2048x1536. 45° field of view. Fundus photo — 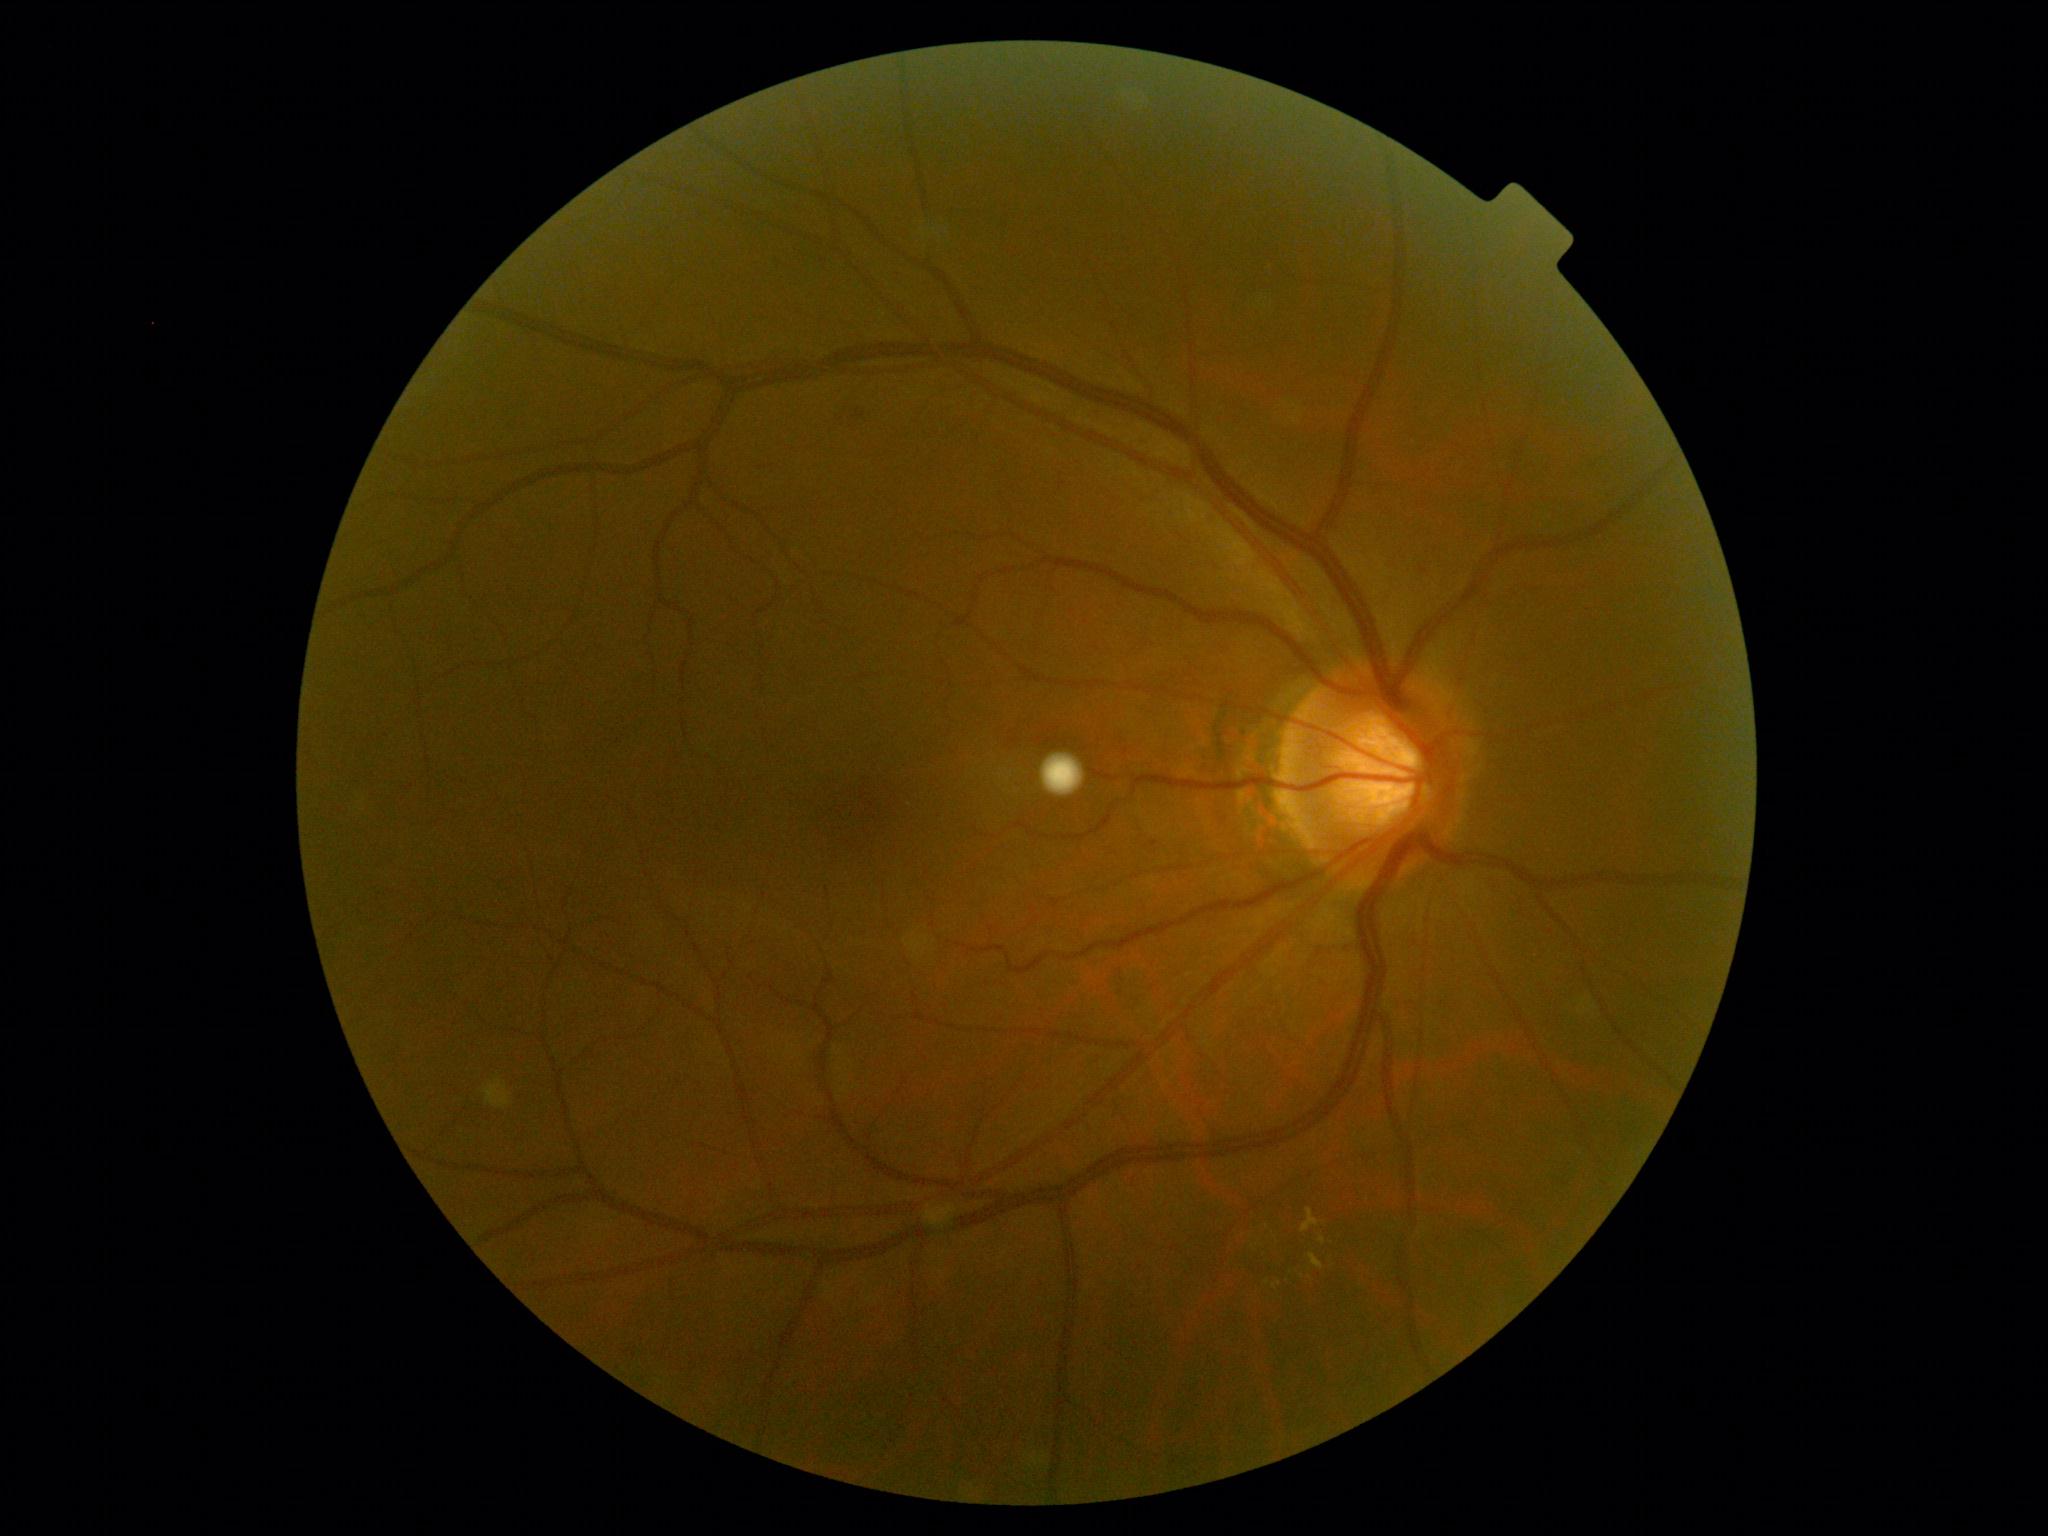 {"dr_grade": "grade 2", "dr_category": "non-proliferative diabetic retinopathy"}